2346 by 1568 pixels, FOV: 45 degrees, retinal fundus photograph: 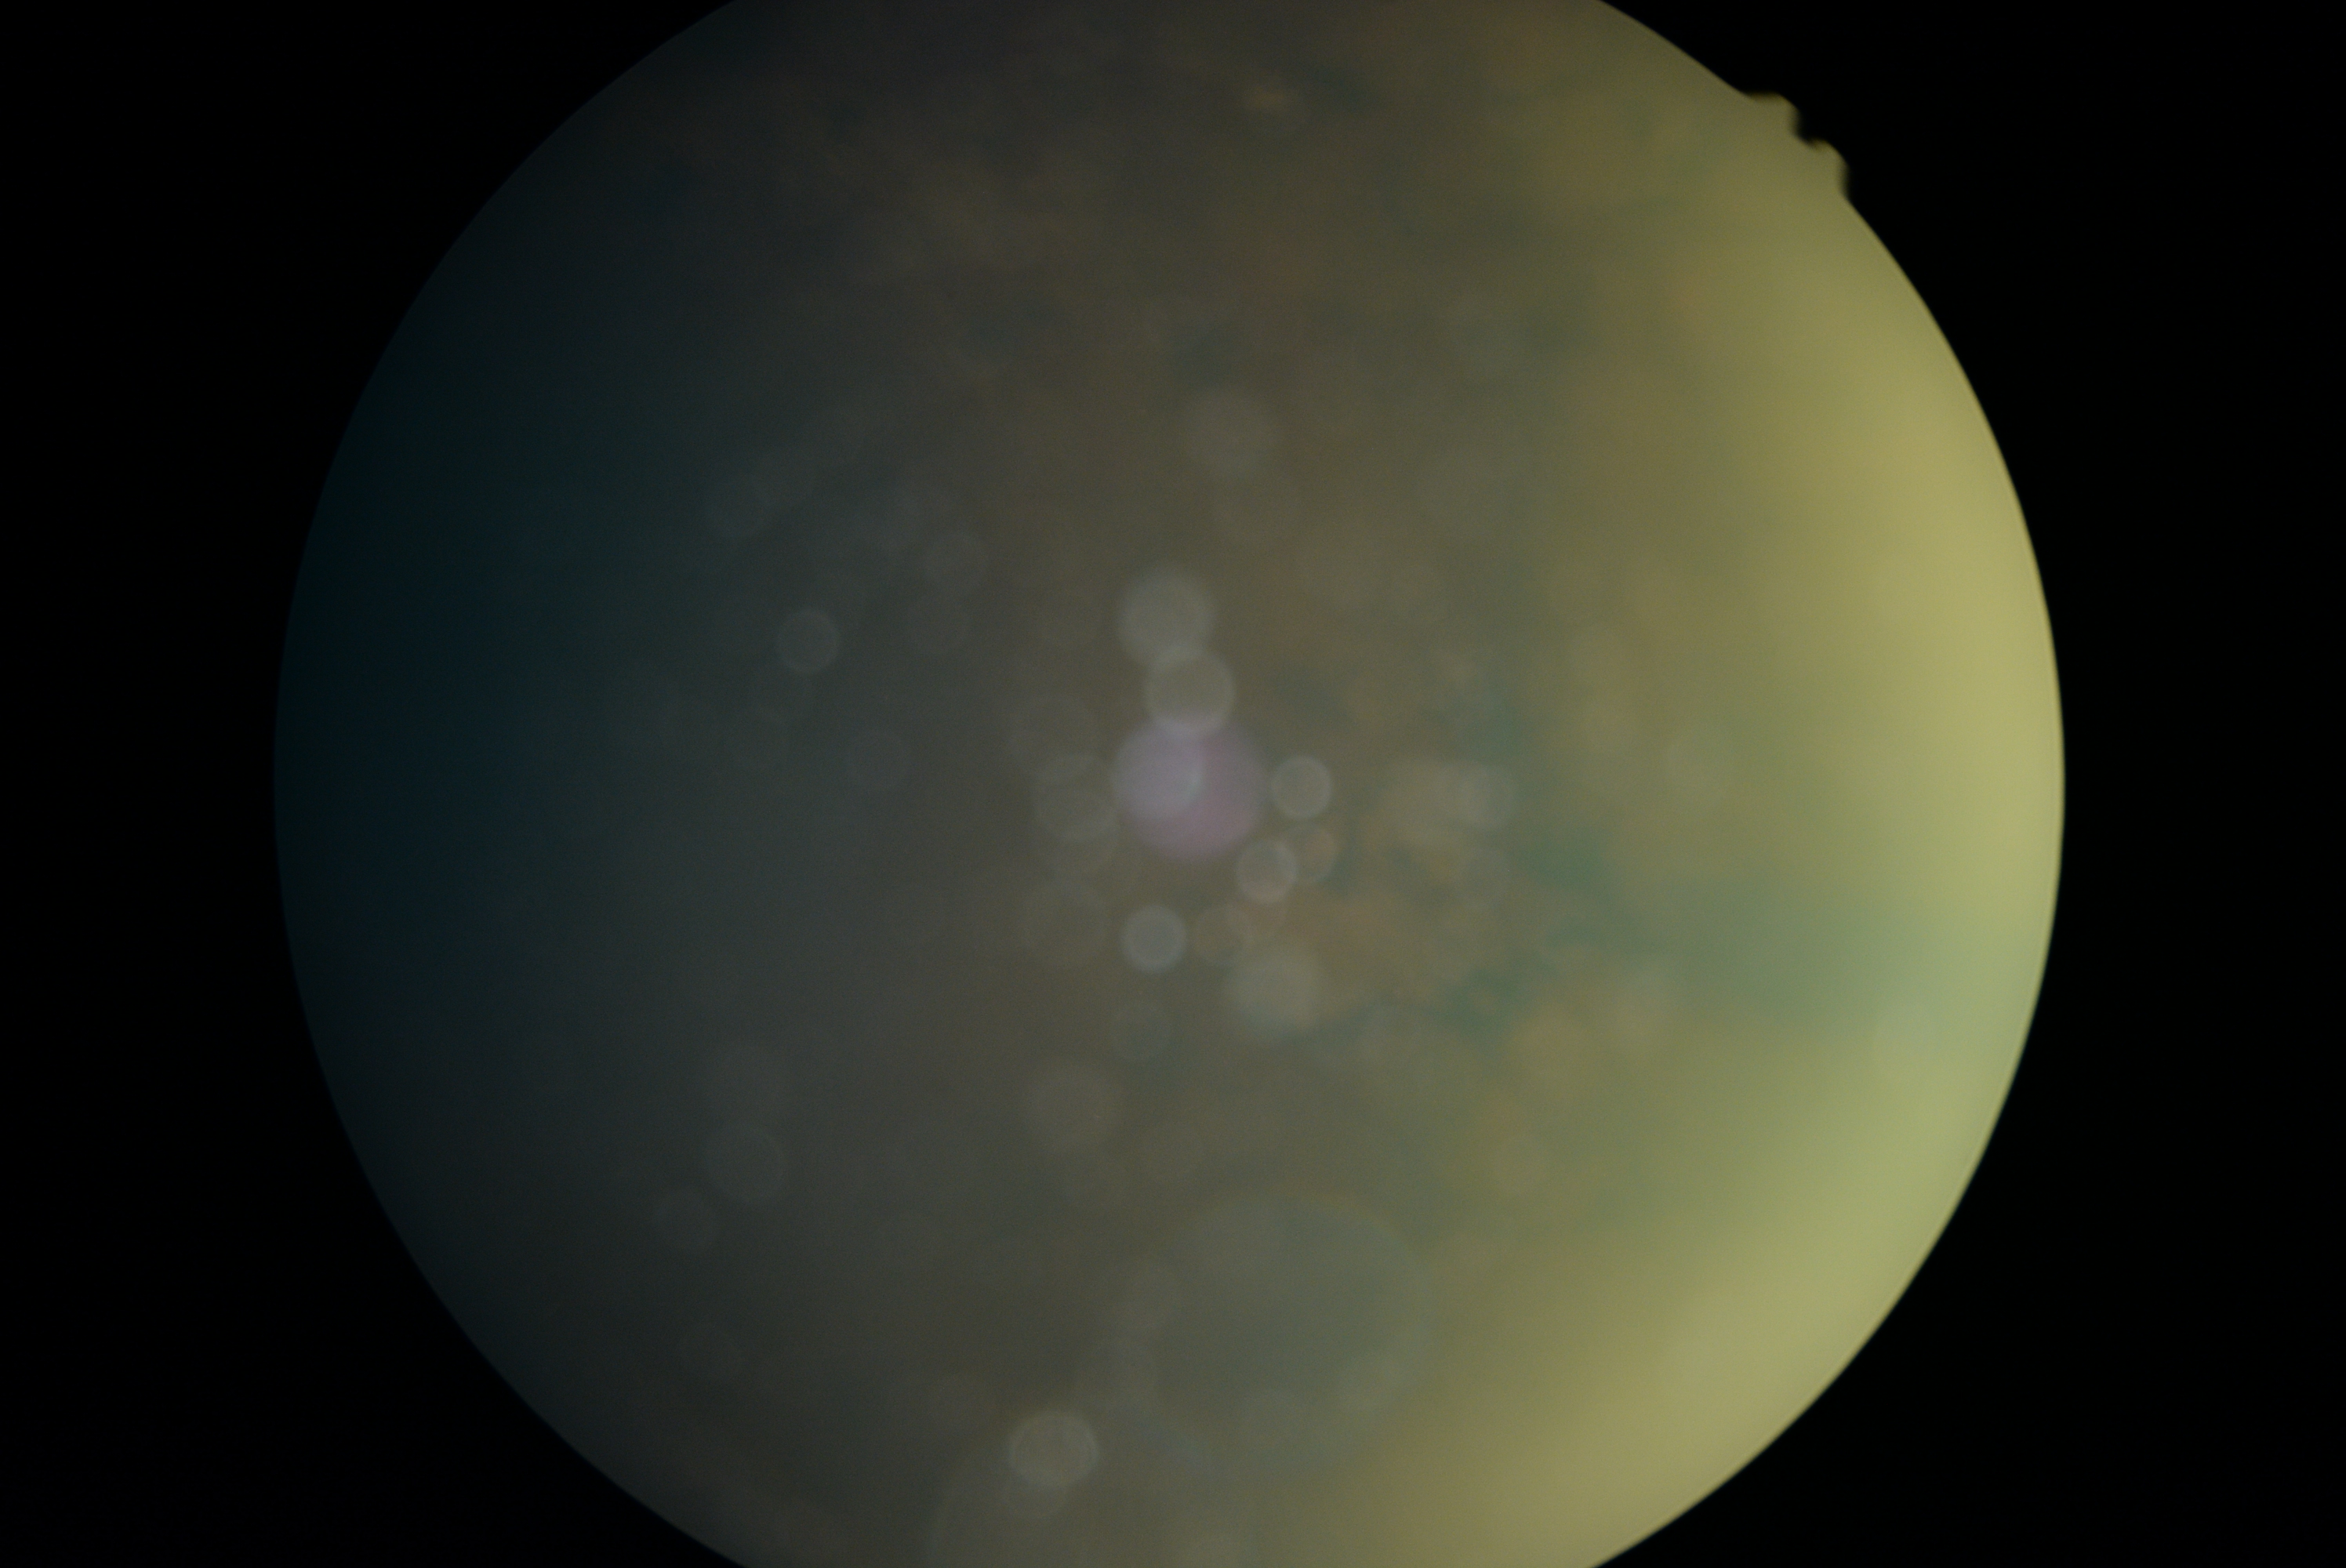 DR stage: ungradable due to poor image quality.